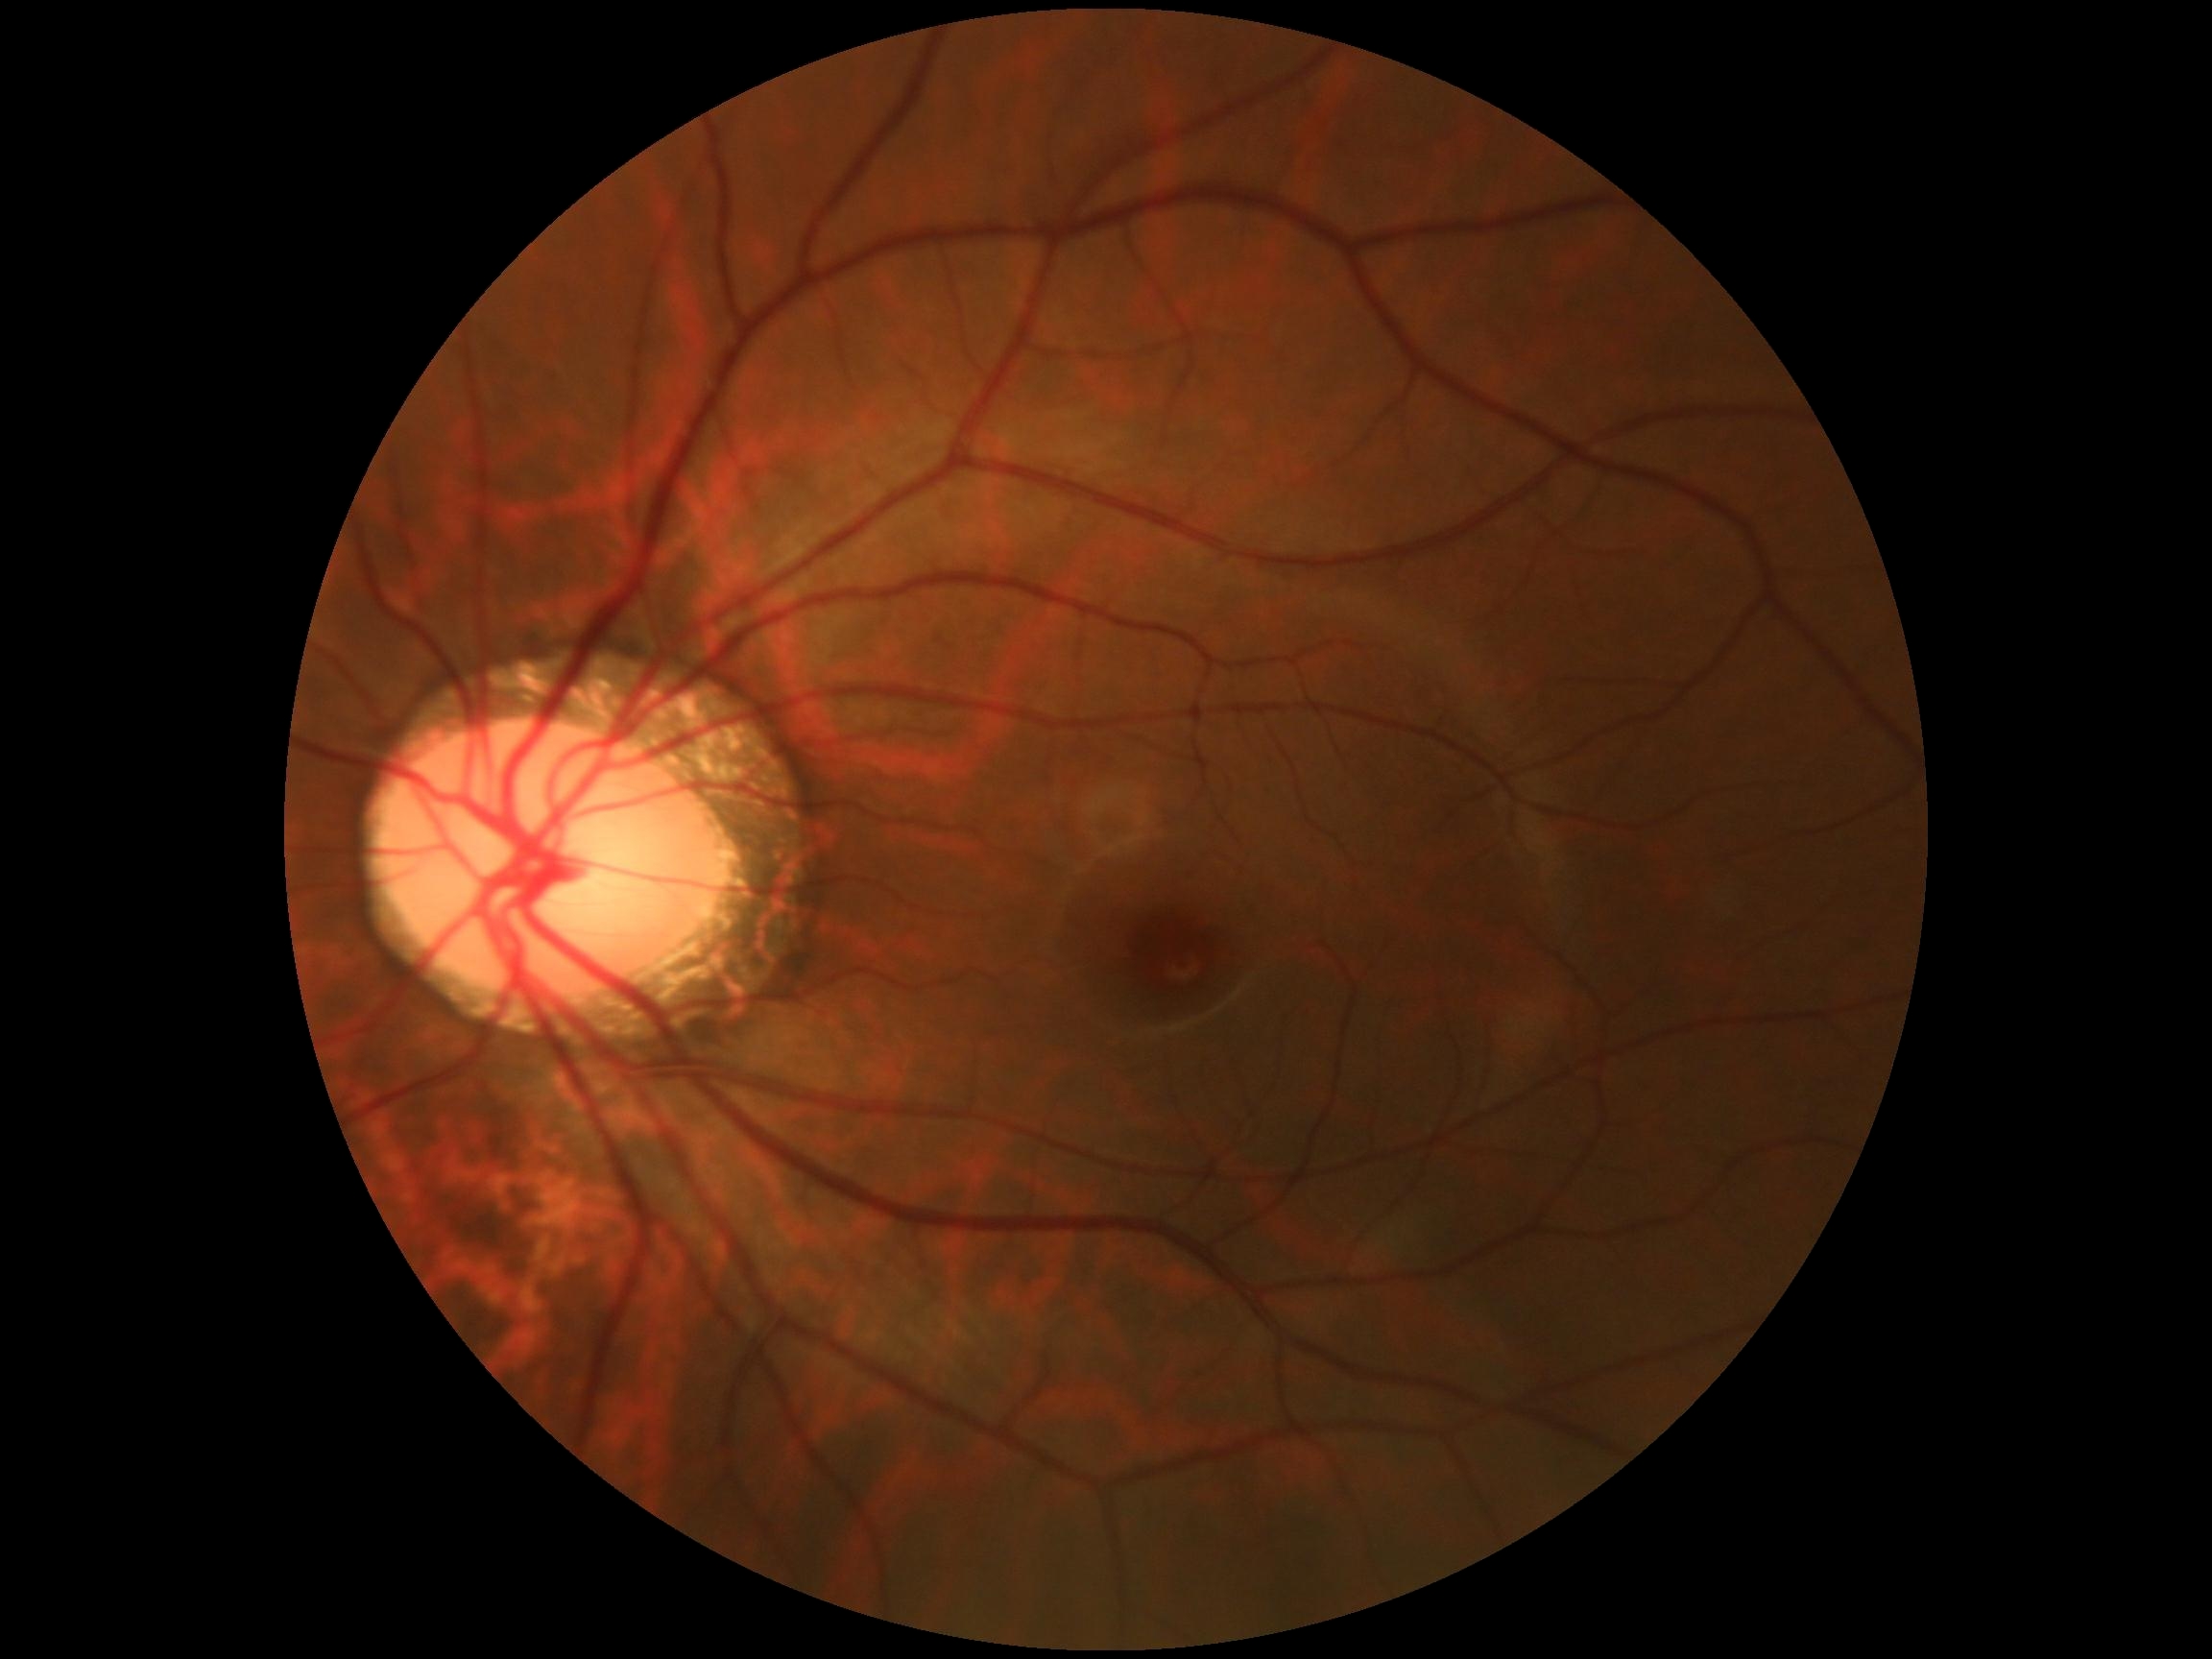 retinopathy grade = 0.